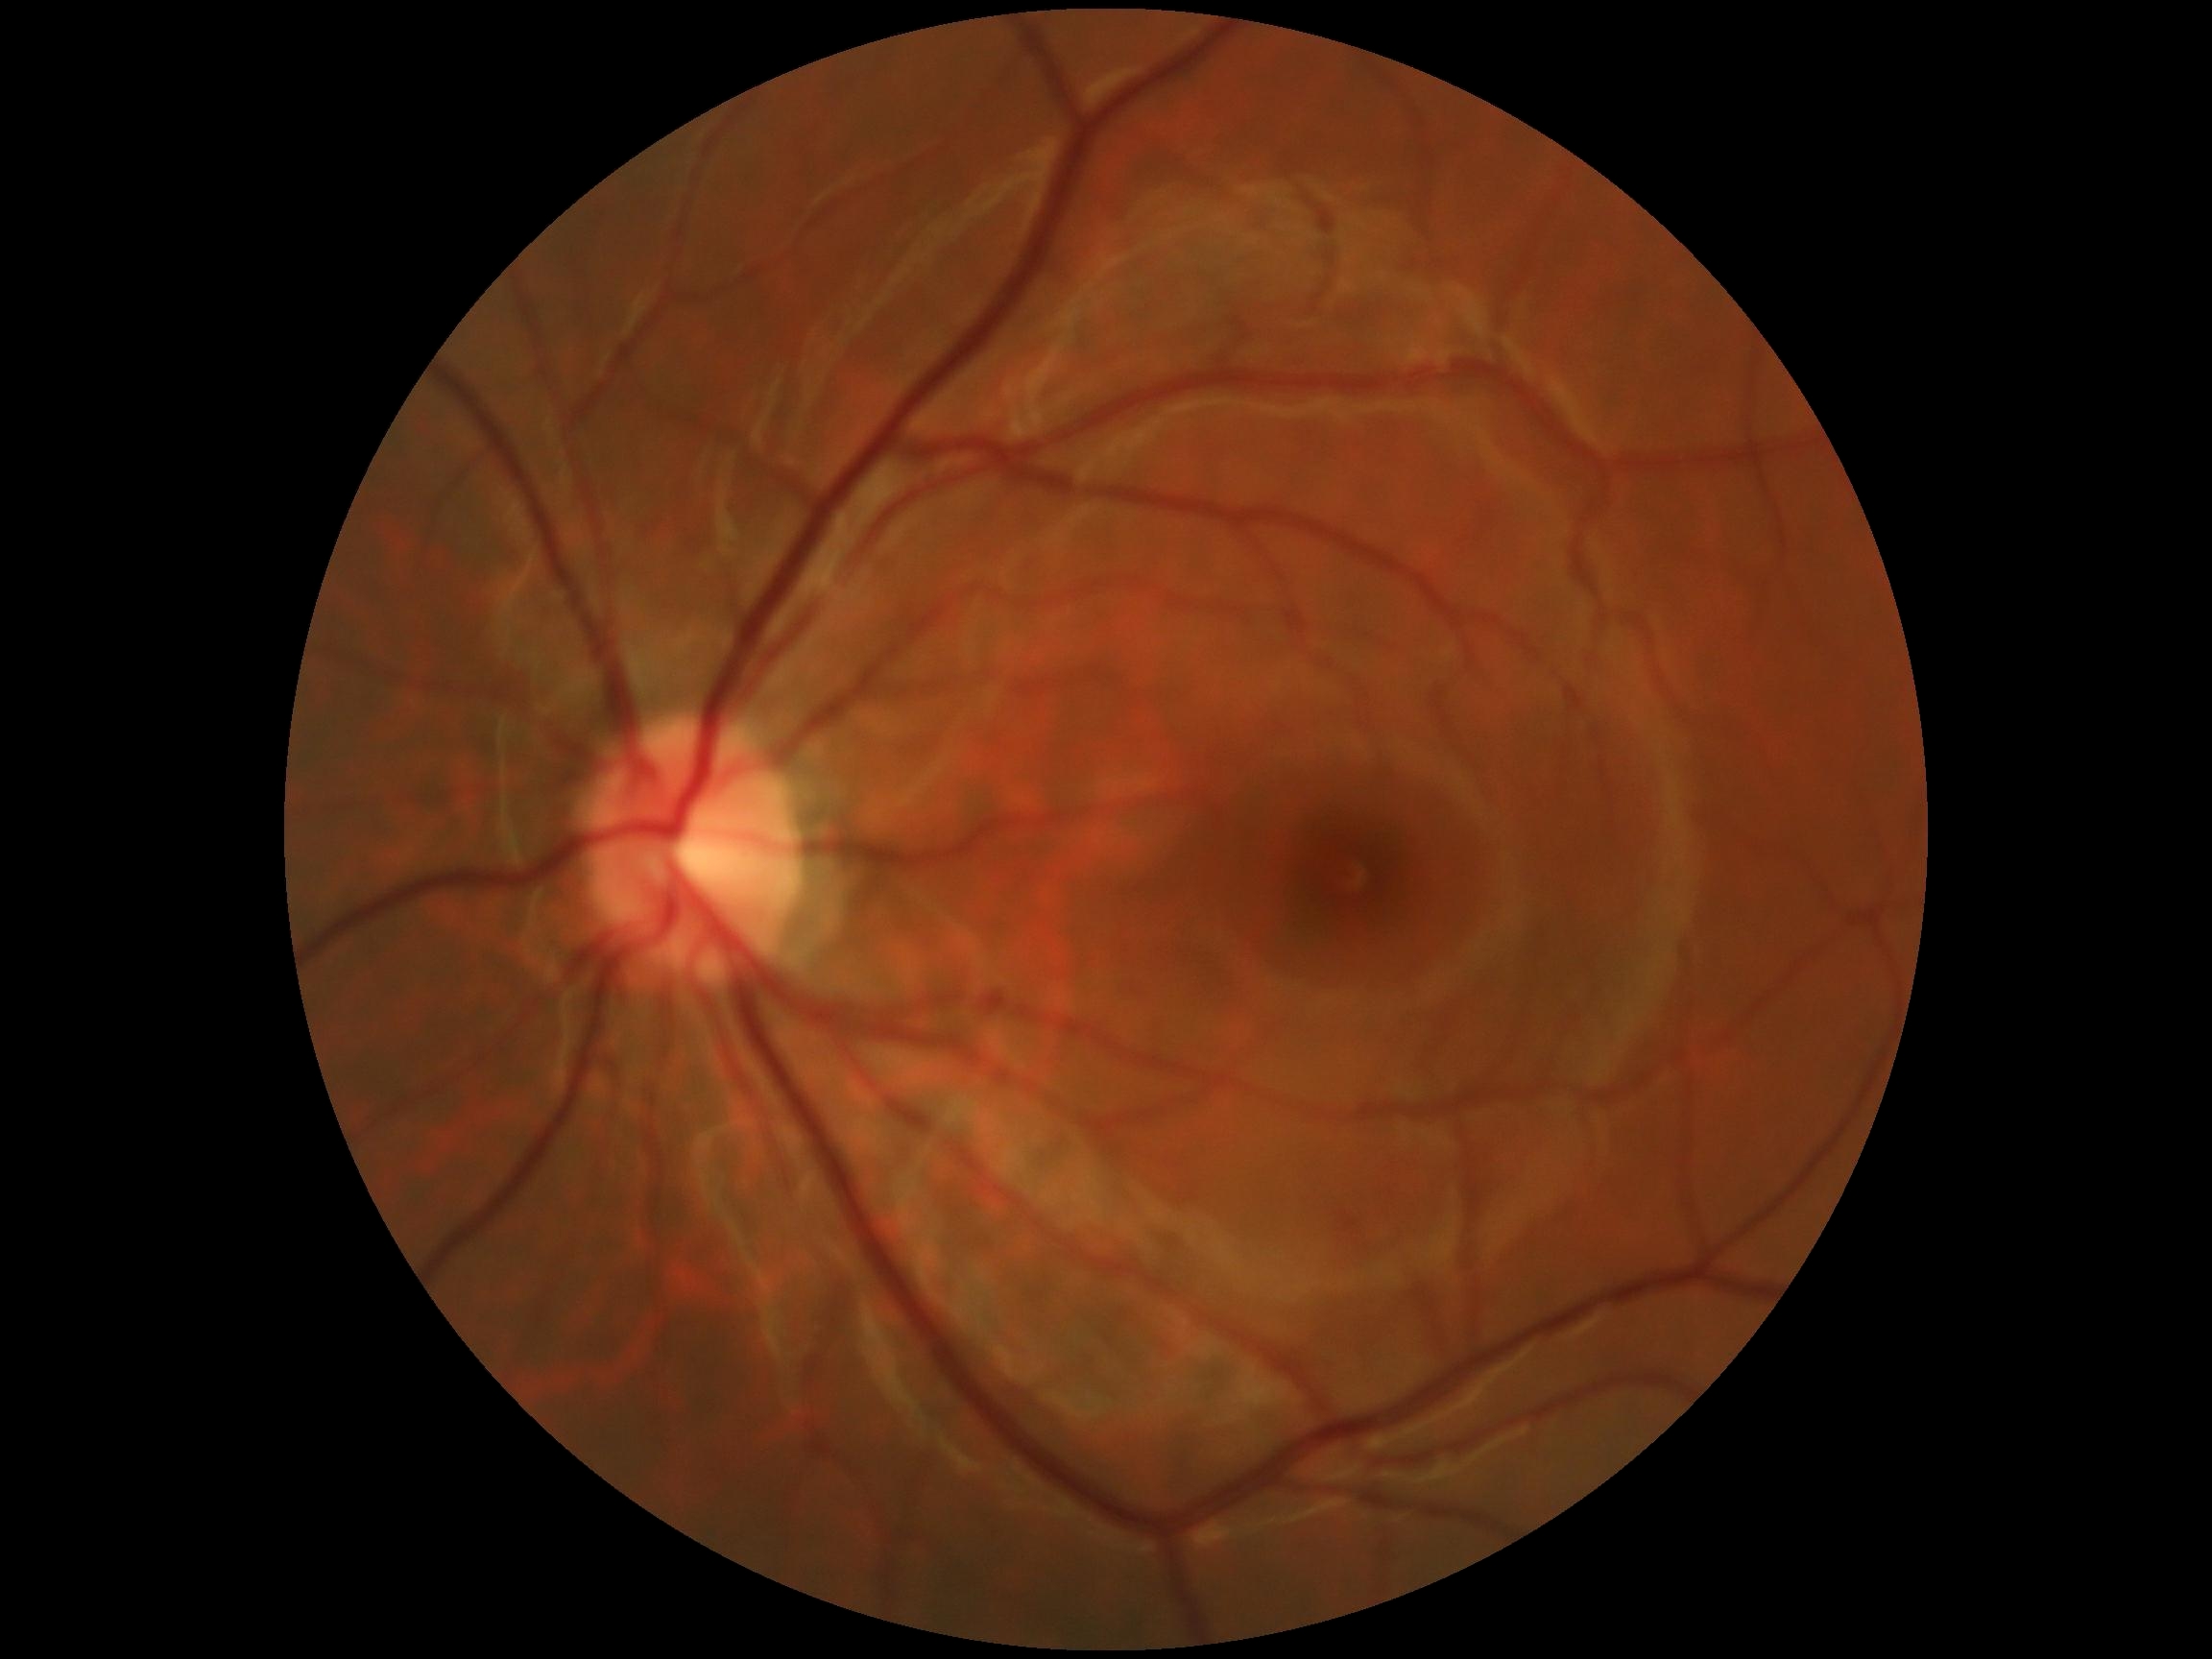
Diabetic retinopathy (DR): grade 0 (no apparent retinopathy).